Graded on the modified Davis scale — 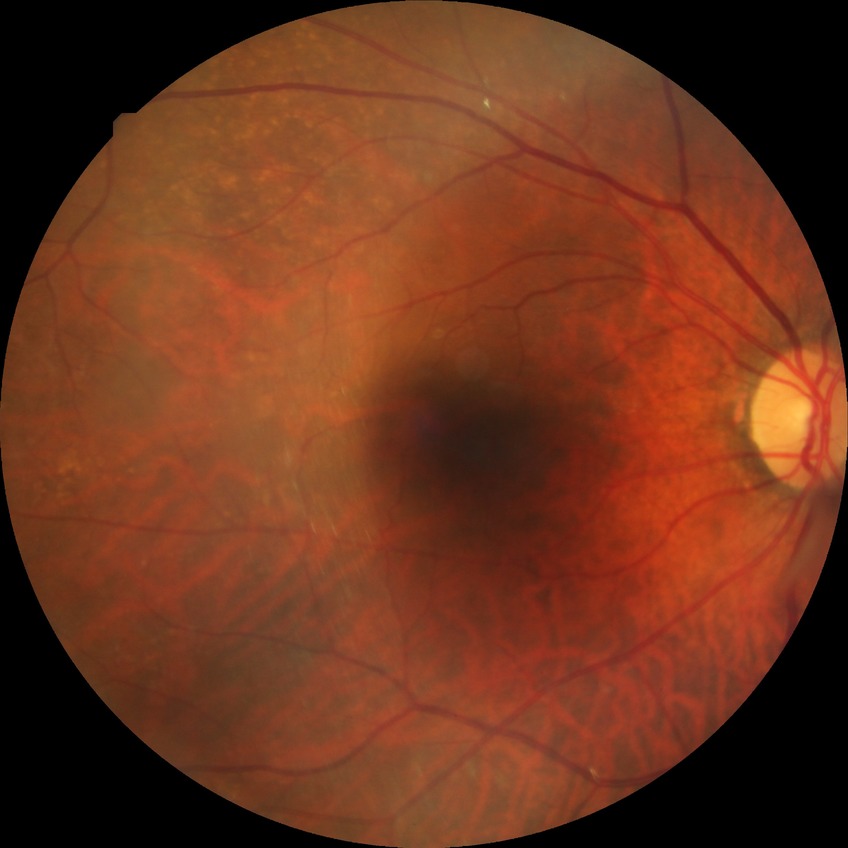
Diabetic retinopathy severity is no diabetic retinopathy.